1960x1897
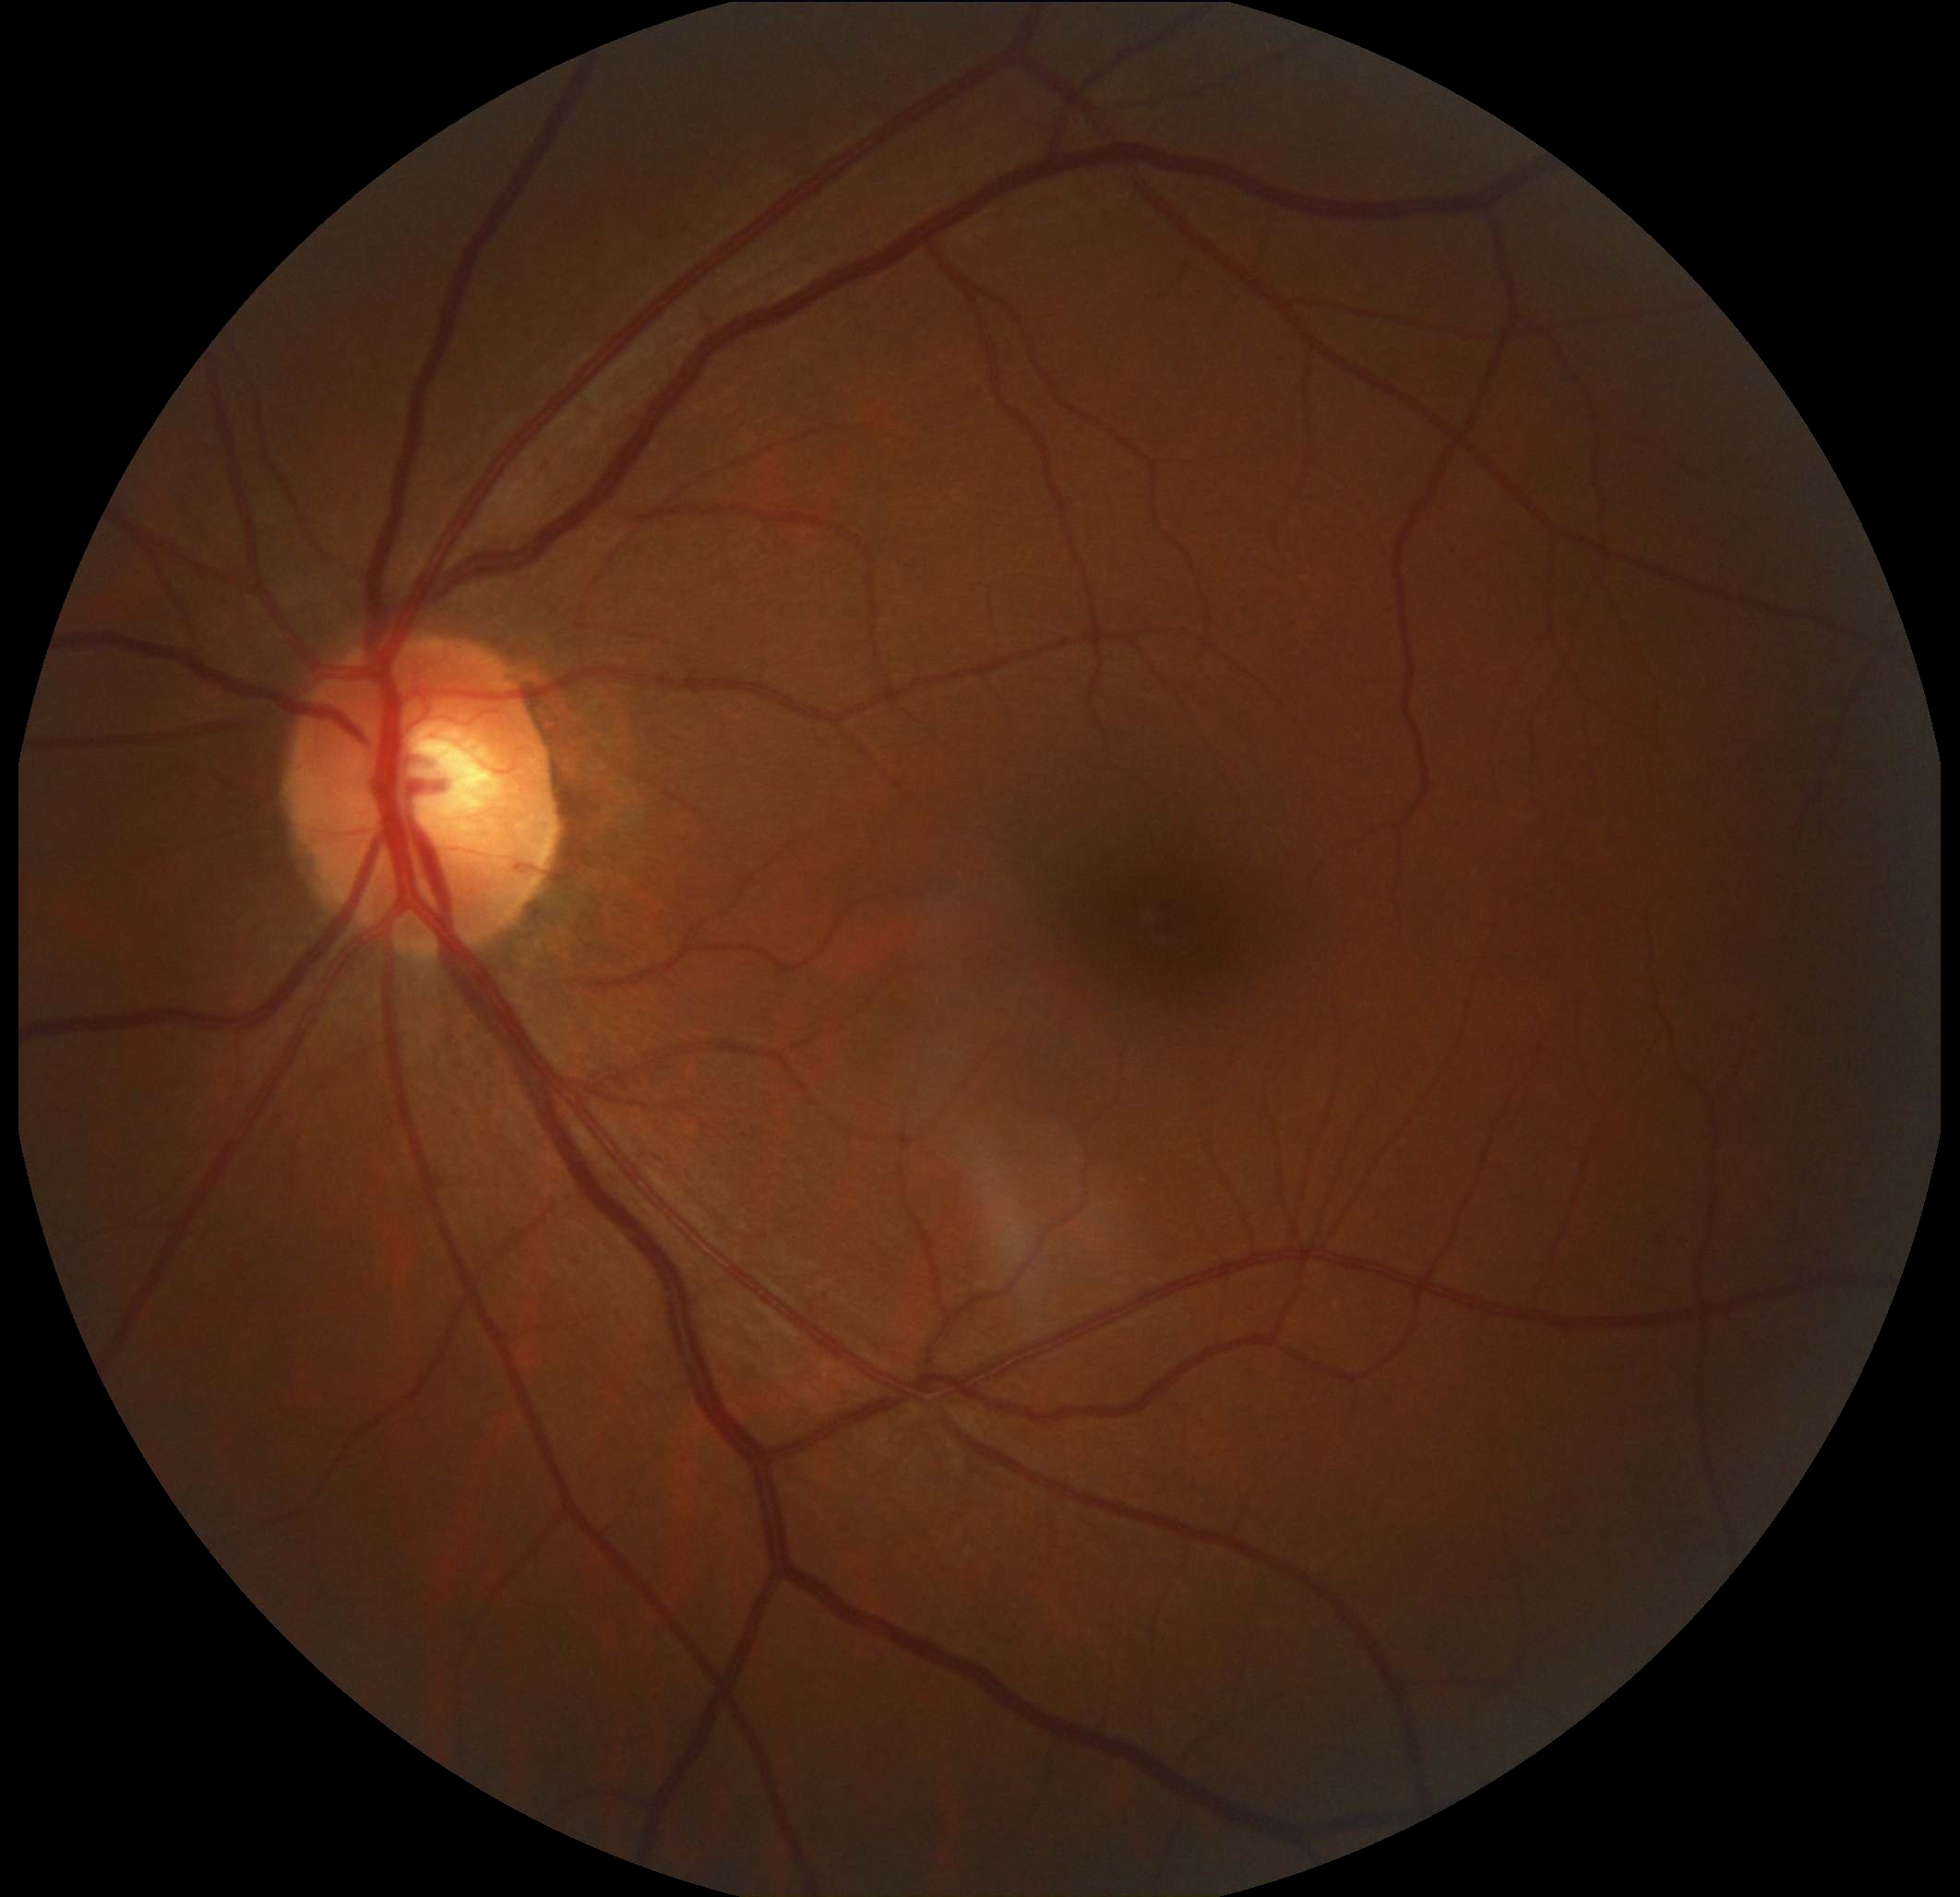
diabetic retinopathy grade = 0 (no apparent retinopathy)